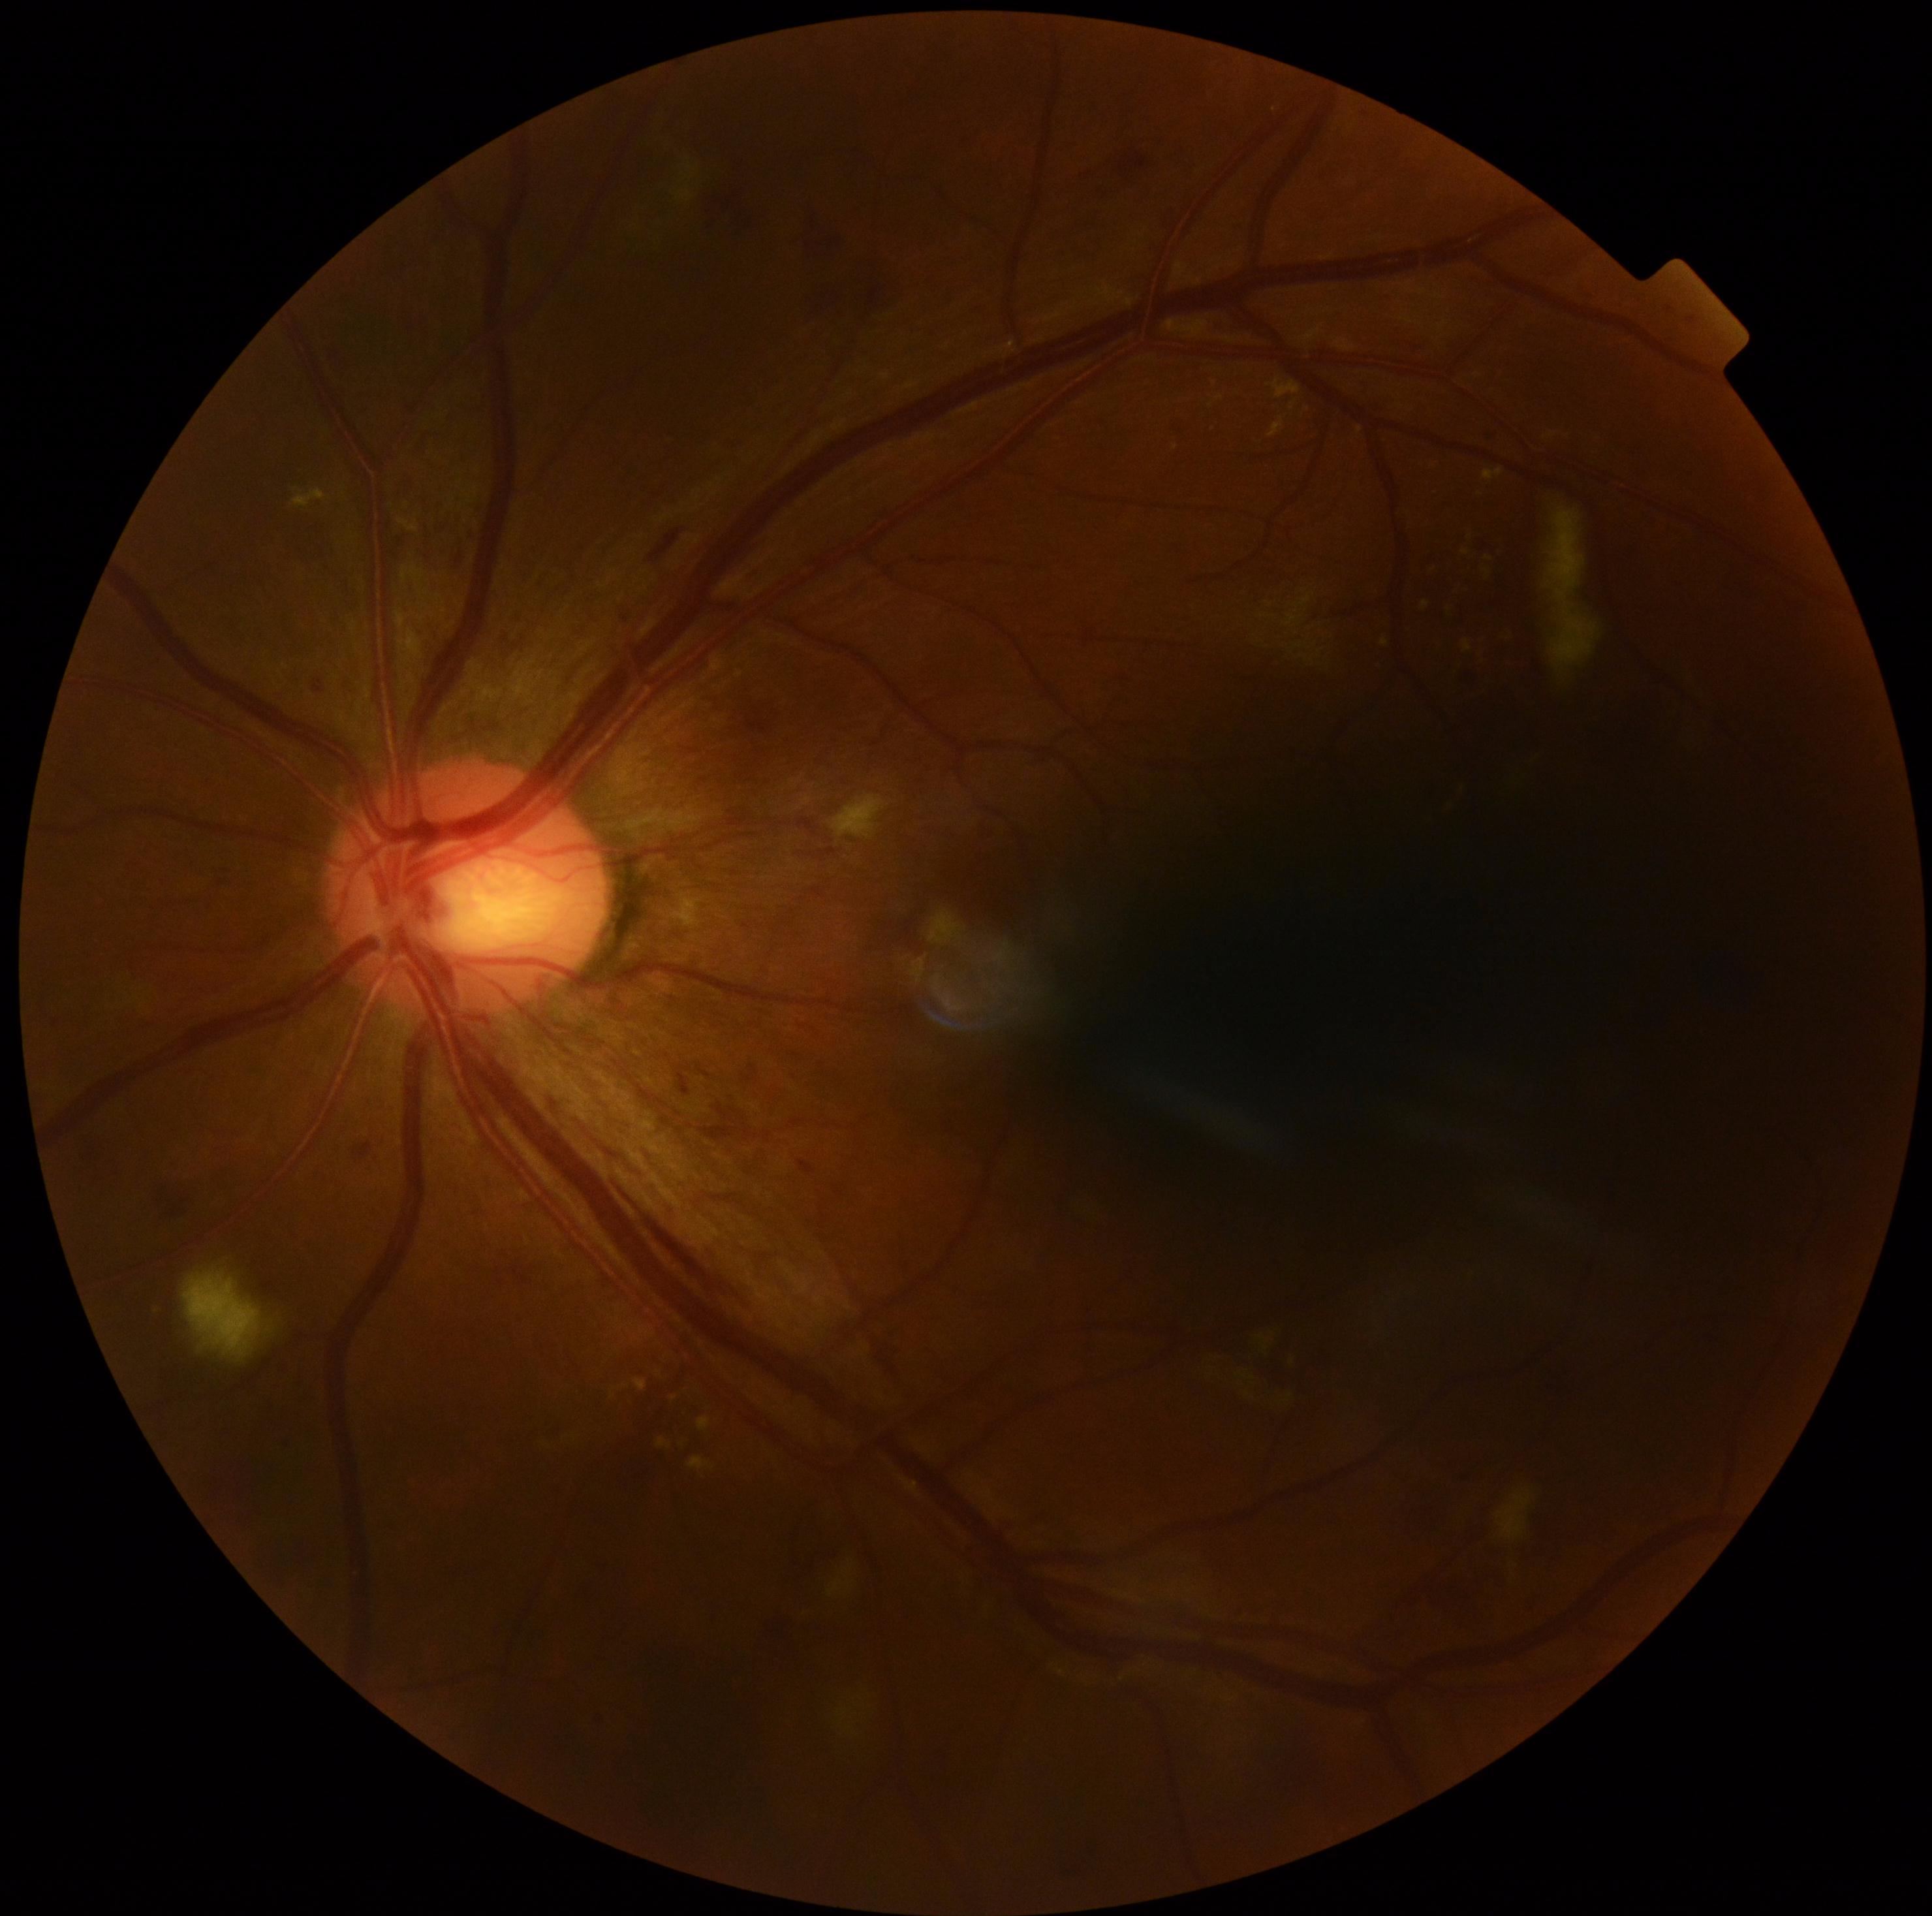
Annotations:
• retinopathy: 2